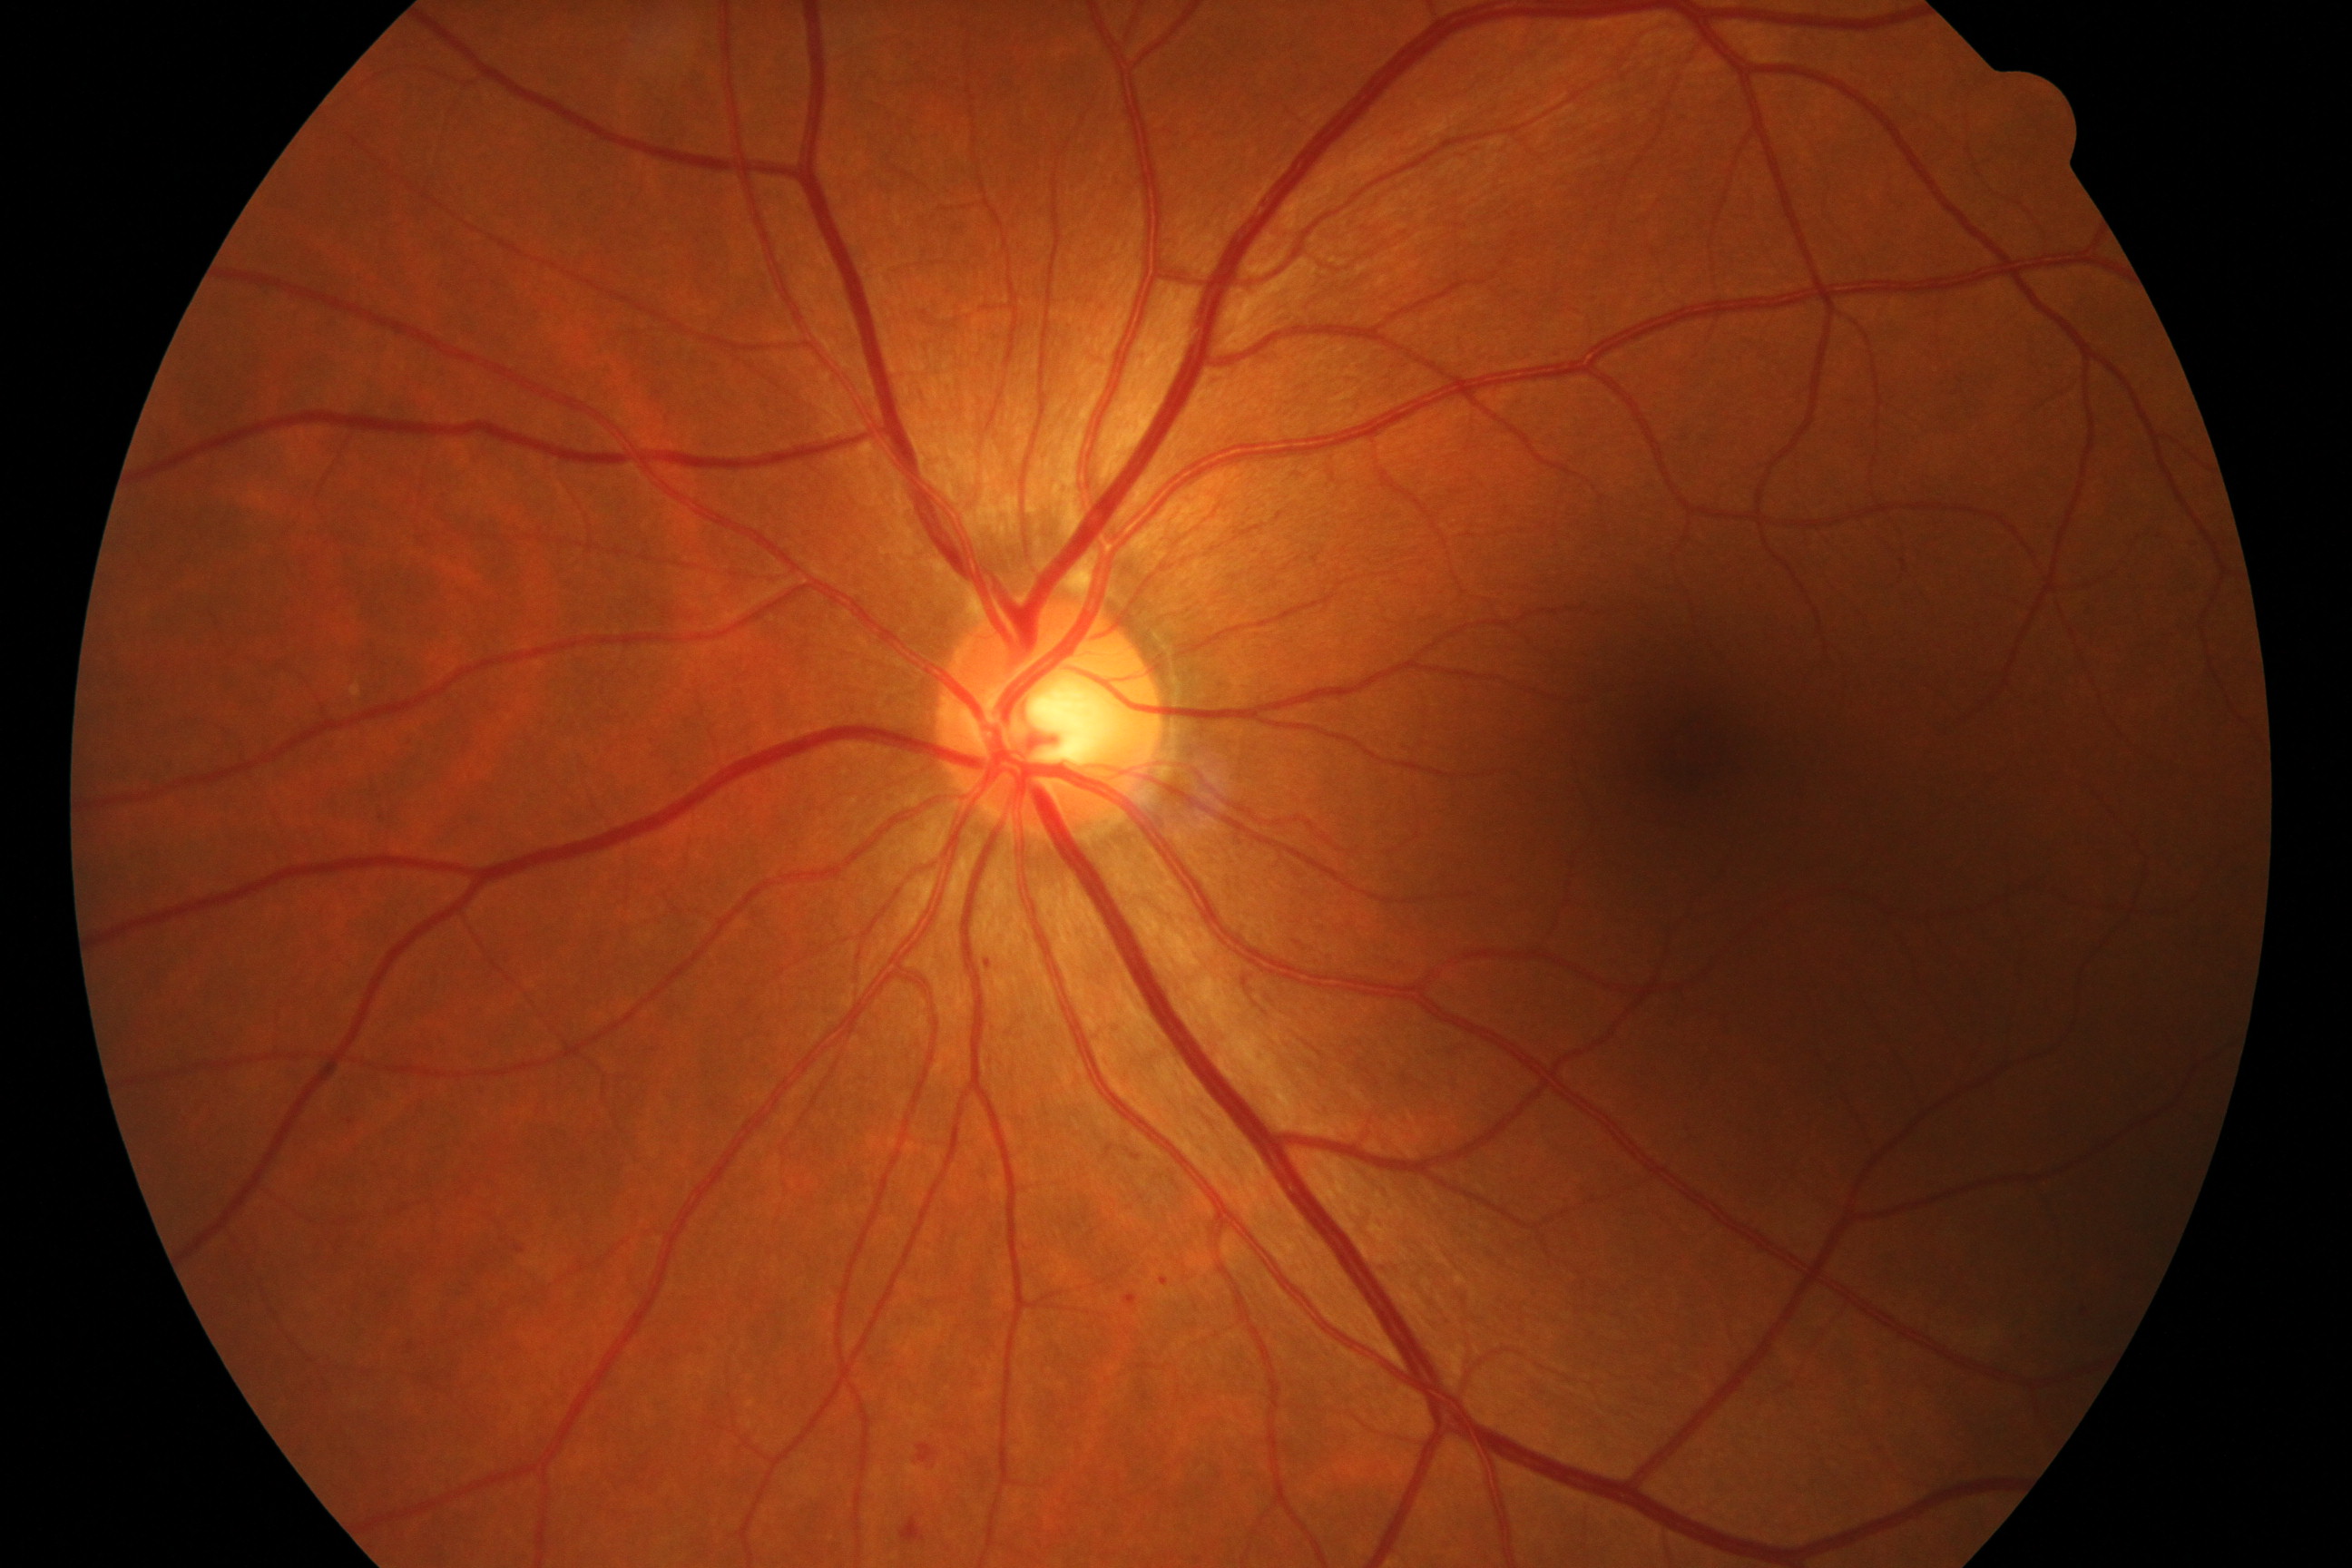

Classification: mild non-proliferative diabetic retinopathy.